Nonmydriatic, diabetic retinopathy graded by the modified Davis classification:
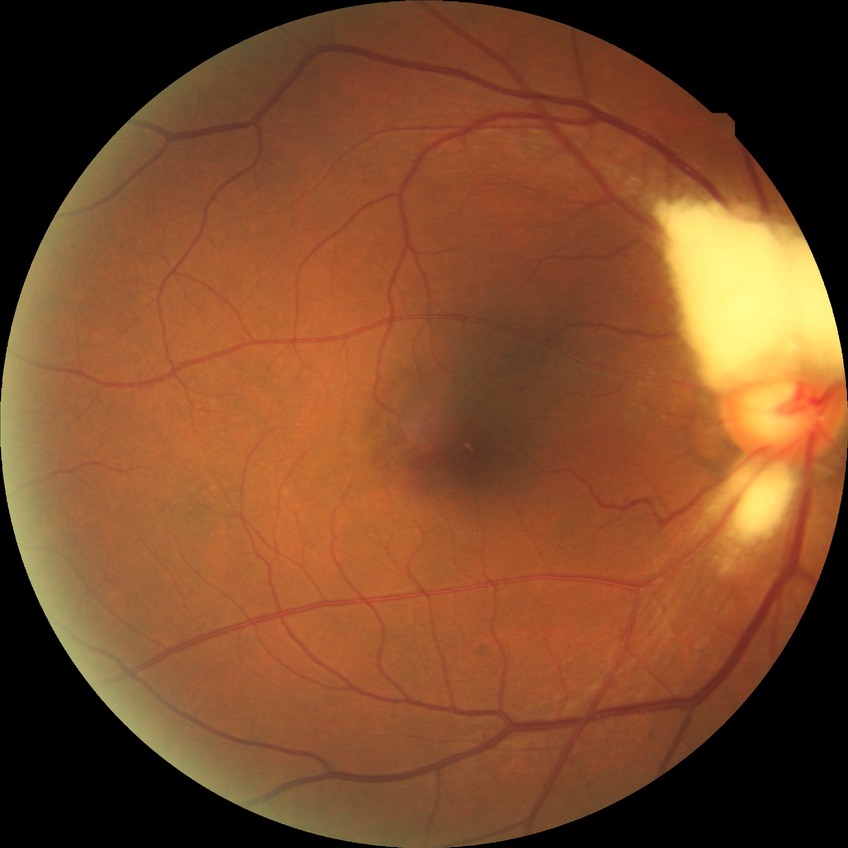

{
  "davis_grade": "no diabetic retinopathy"
}